45-degree field of view. 2352 by 1568 pixels. Fundus photo:
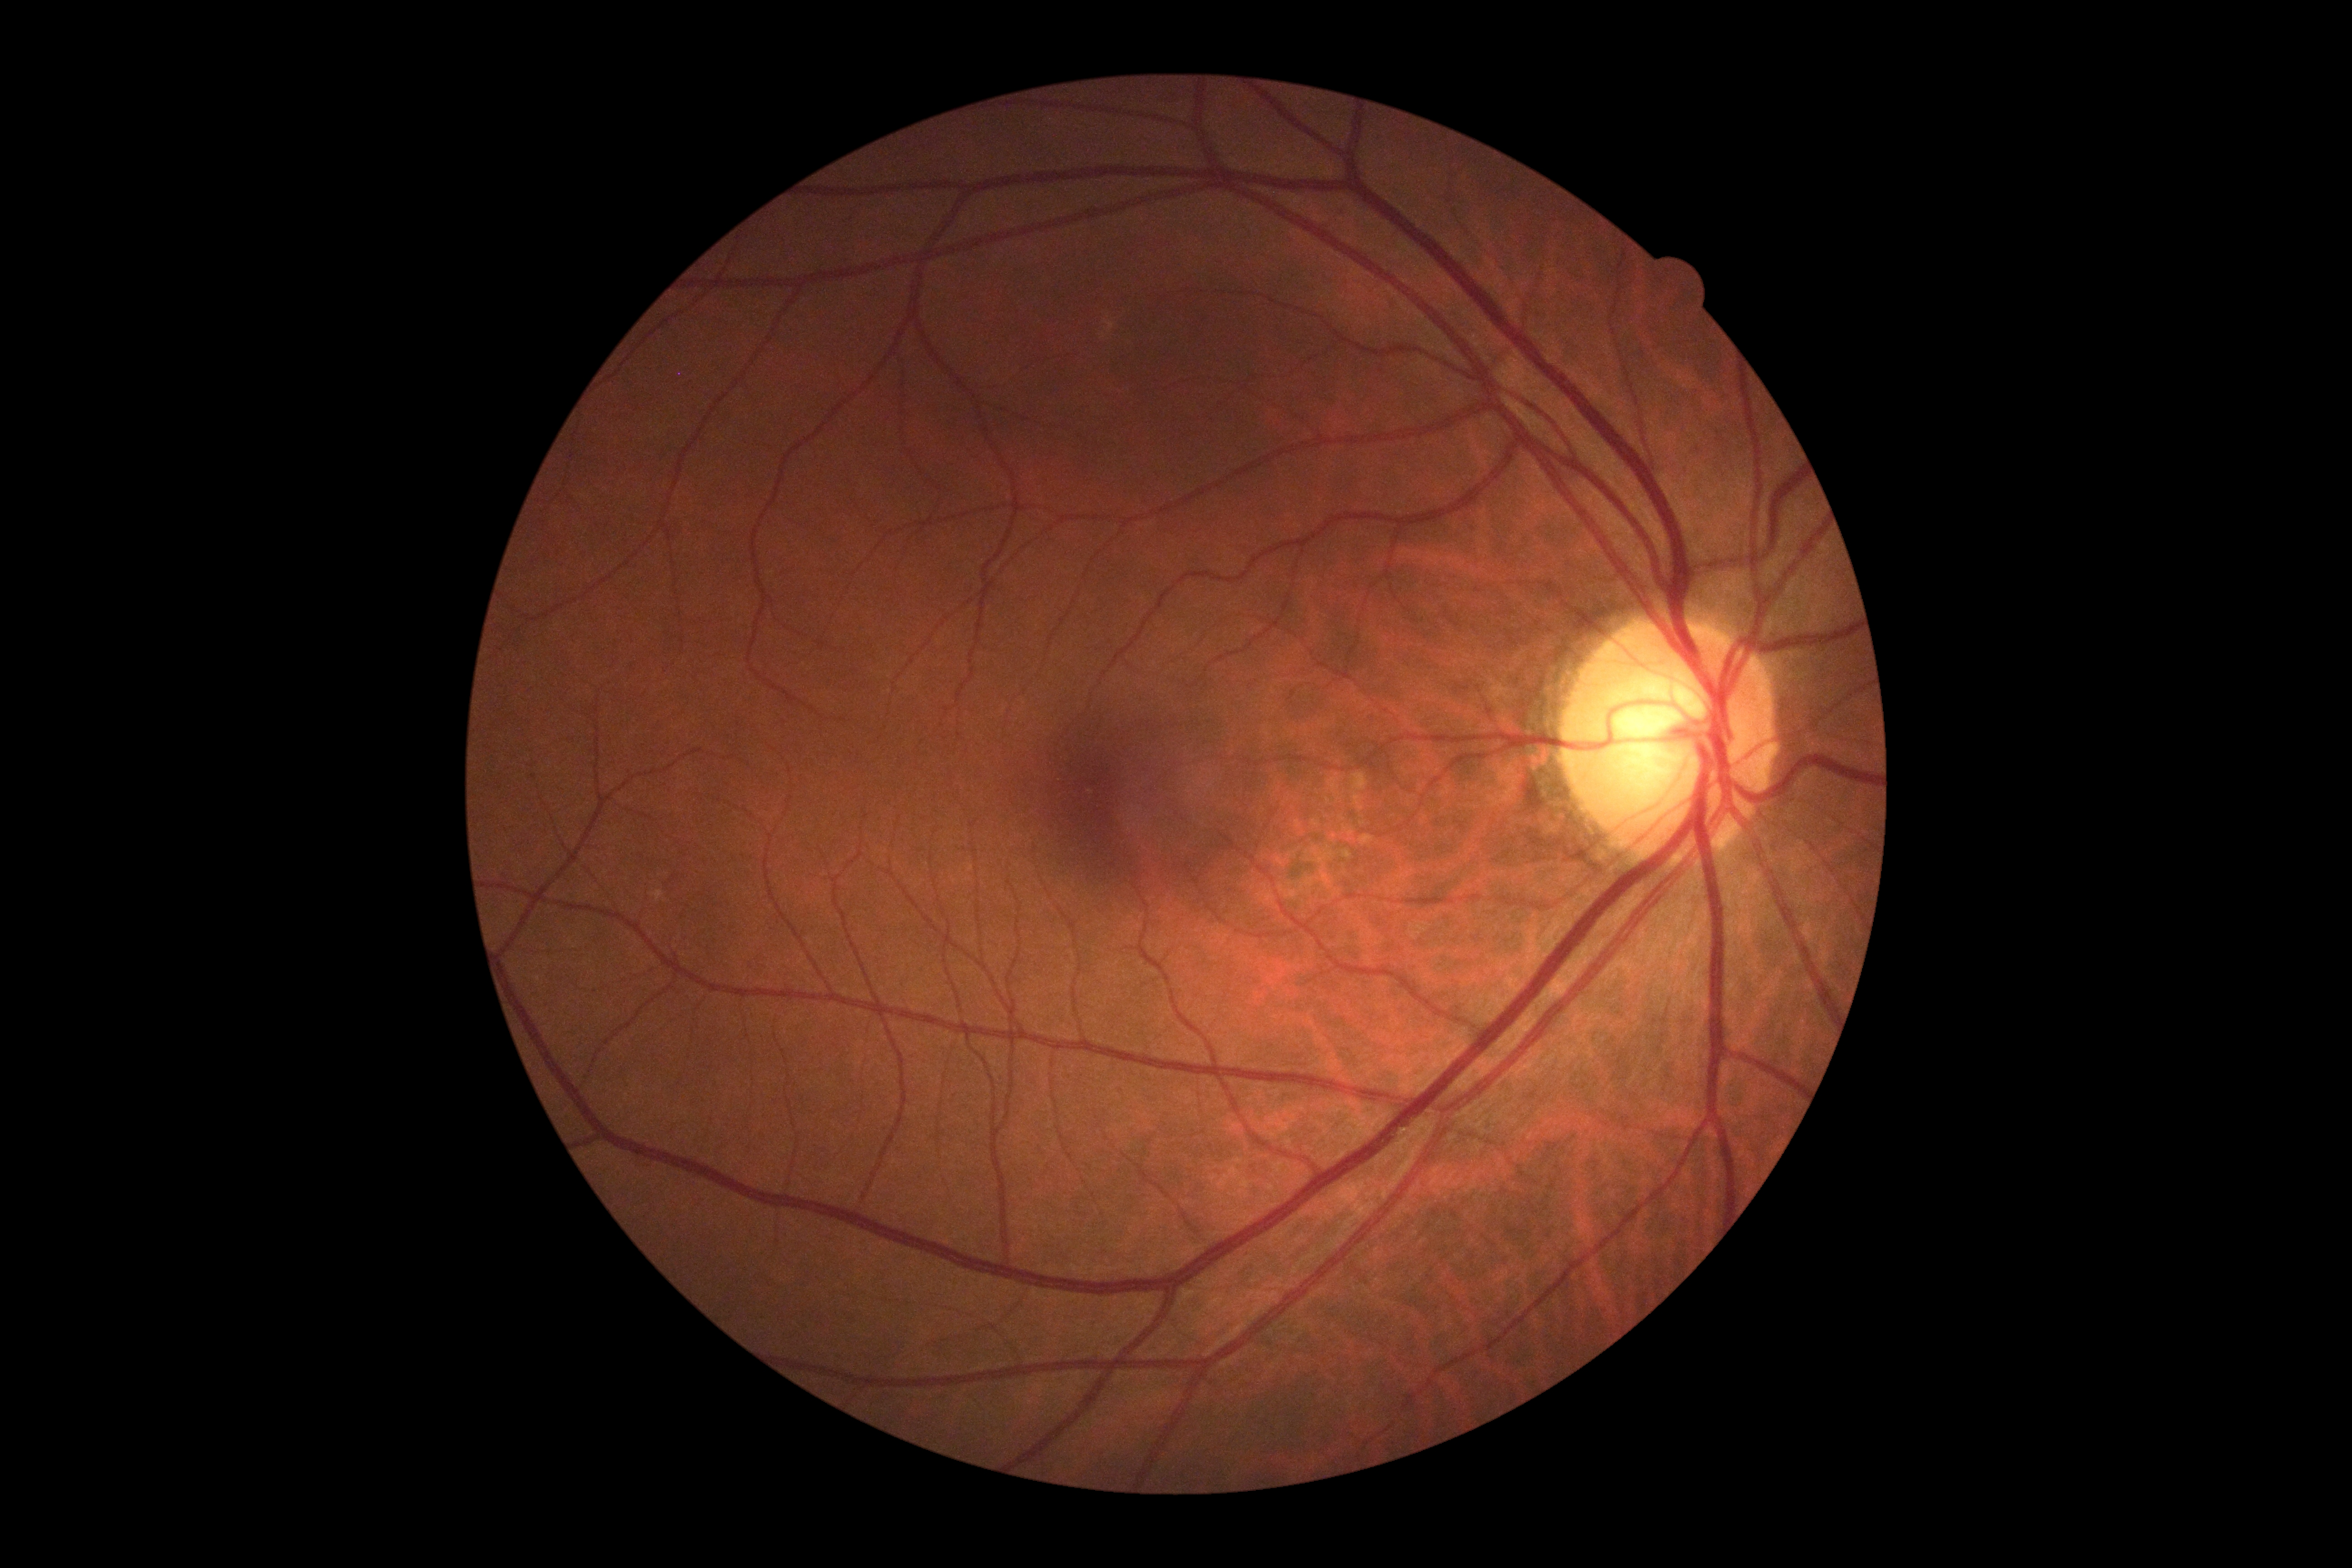 Diabetic retinopathy: grade 0 (no apparent retinopathy) — no visible signs of diabetic retinopathy.